Image size 848x848, color fundus photograph
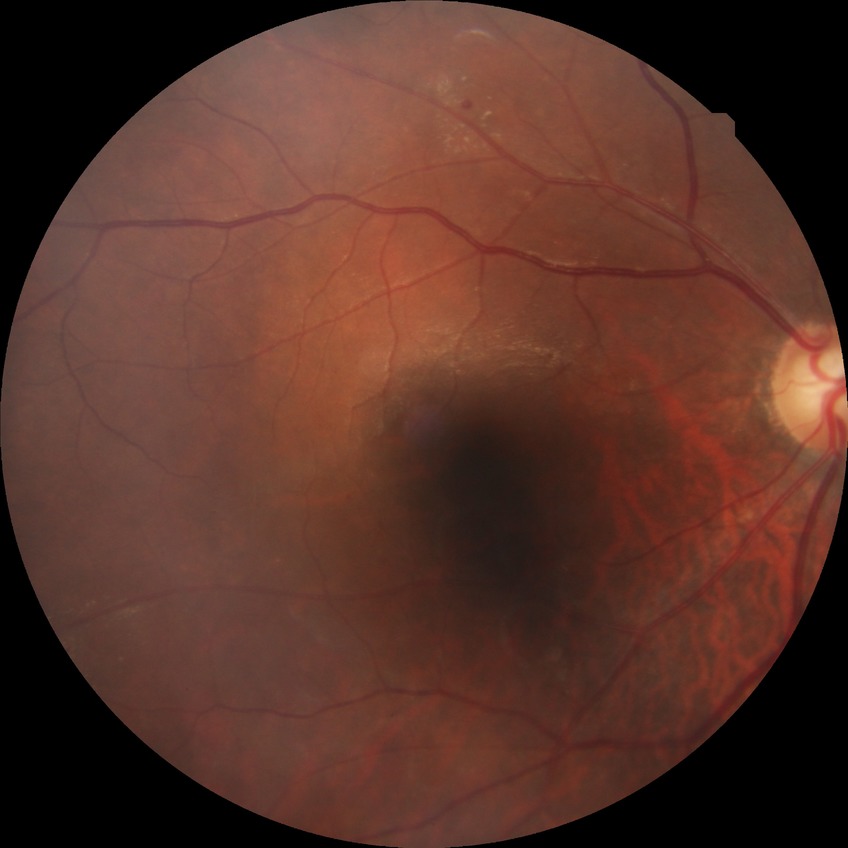
DR stage is SDR.